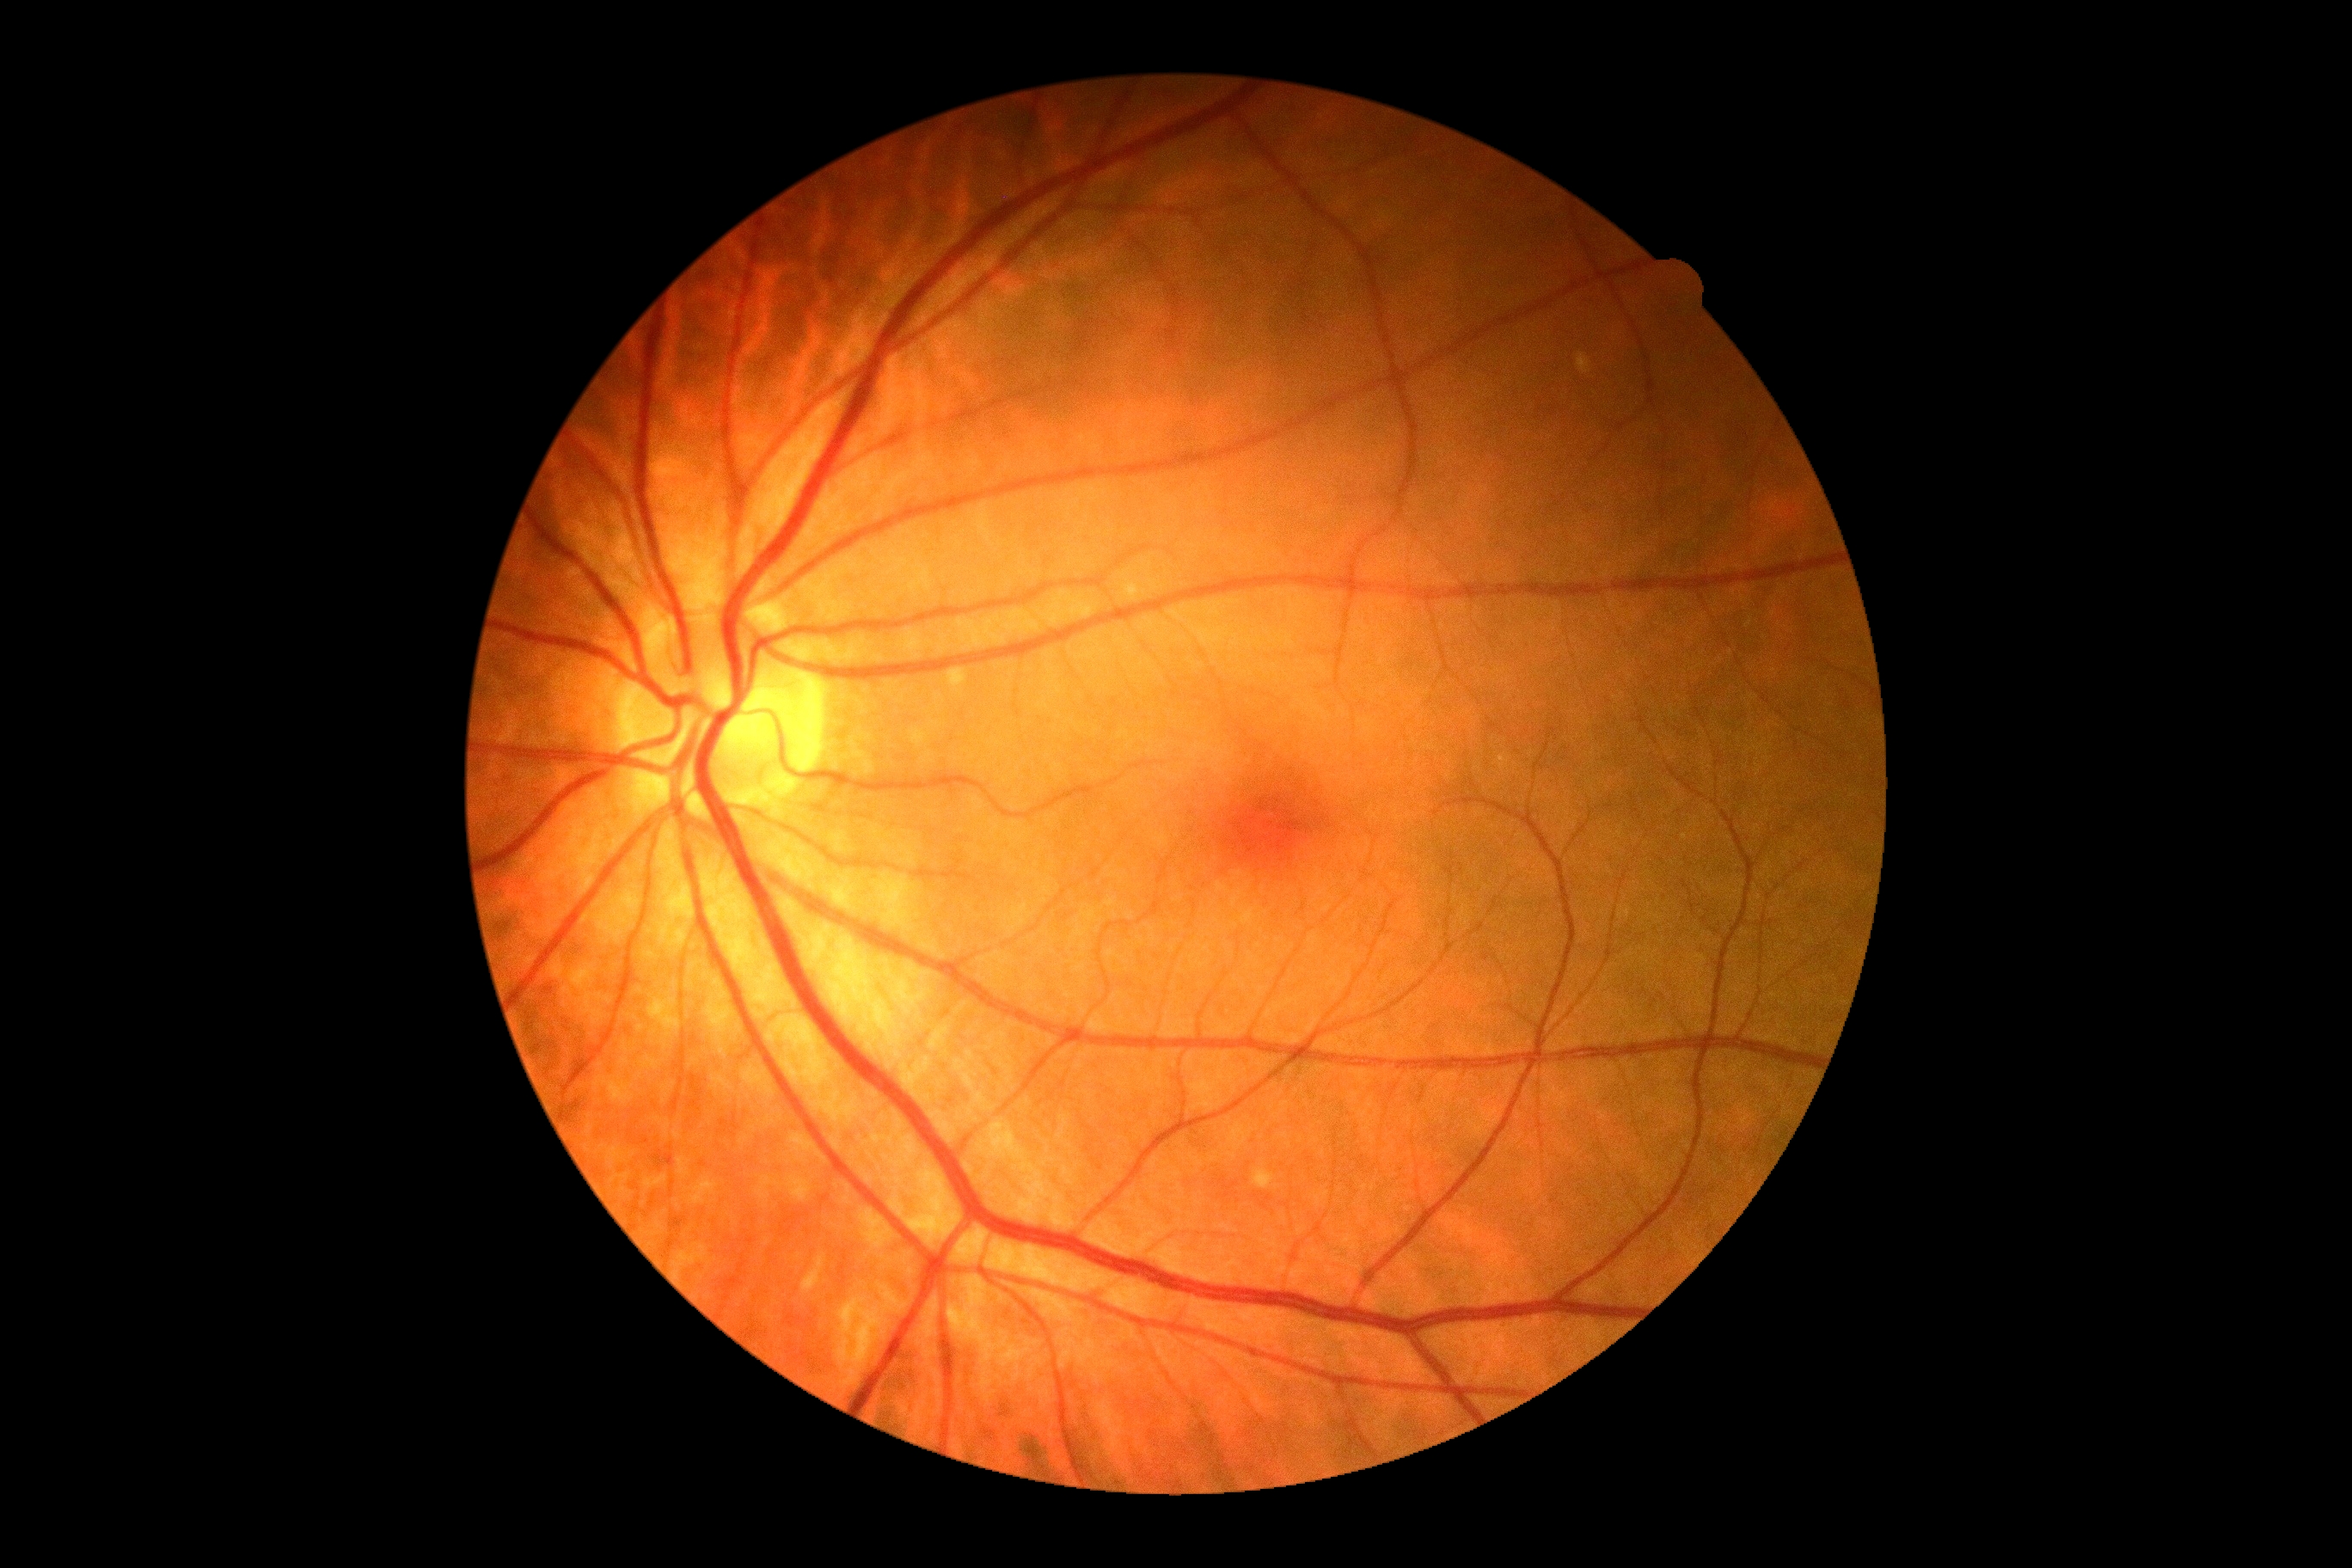 No apparent diabetic retinopathy. Diabetic retinopathy grade is 0.